Fundus photo; 45° field of view; diabetic retinopathy graded by the modified Davis classification; no pharmacologic dilation; acquired with a NIDEK AFC-230 — 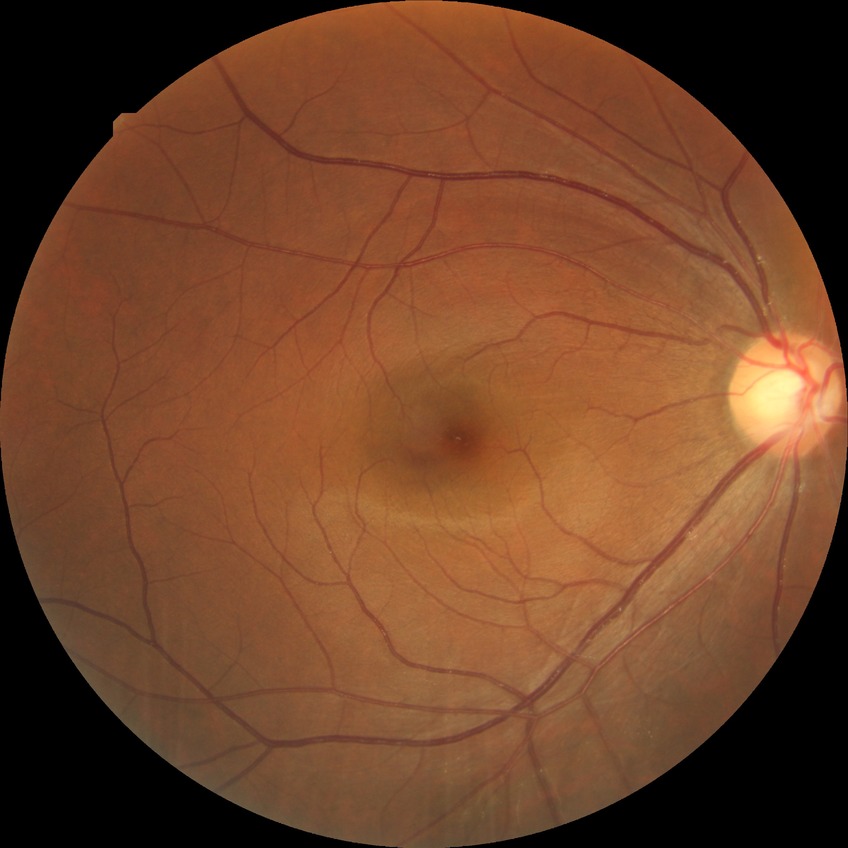 DR stage: NDR.